Nonmydriatic fundus photograph, color fundus image, NIDEK AFC-230
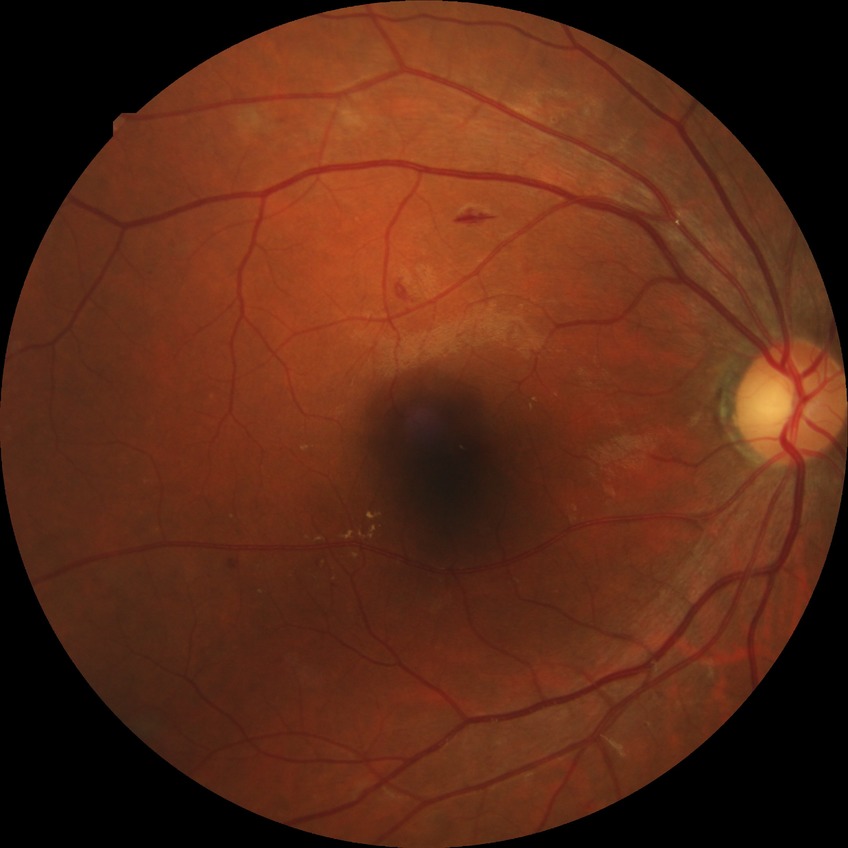

Modified Davis grading: pre-proliferative diabetic retinopathy.